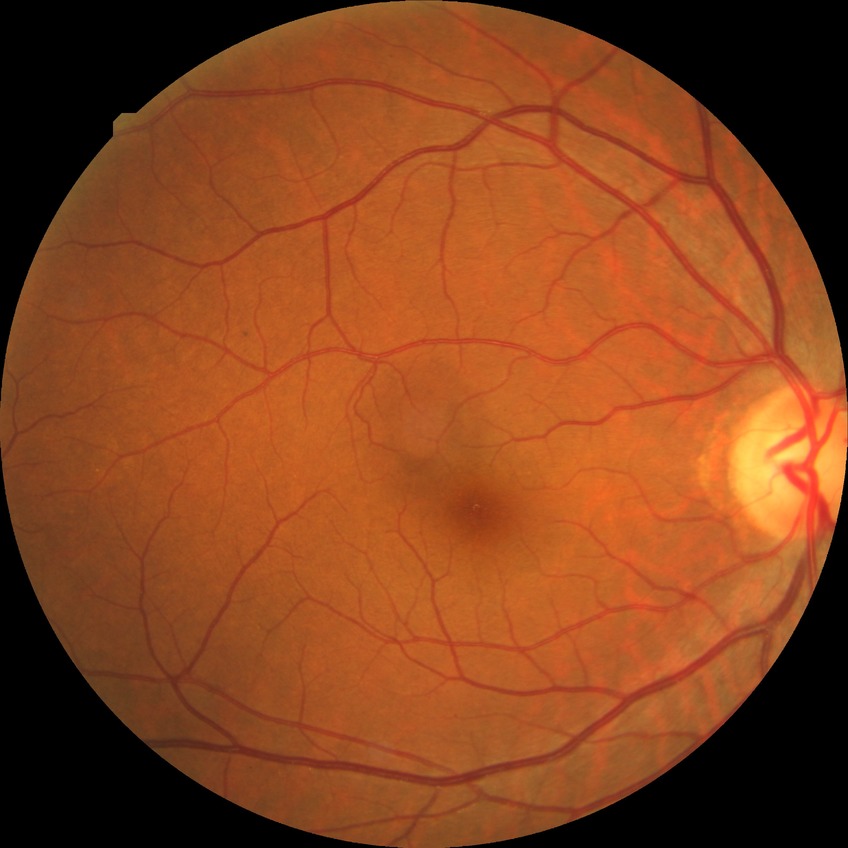

Davis stage: SDR.